2352x1568: 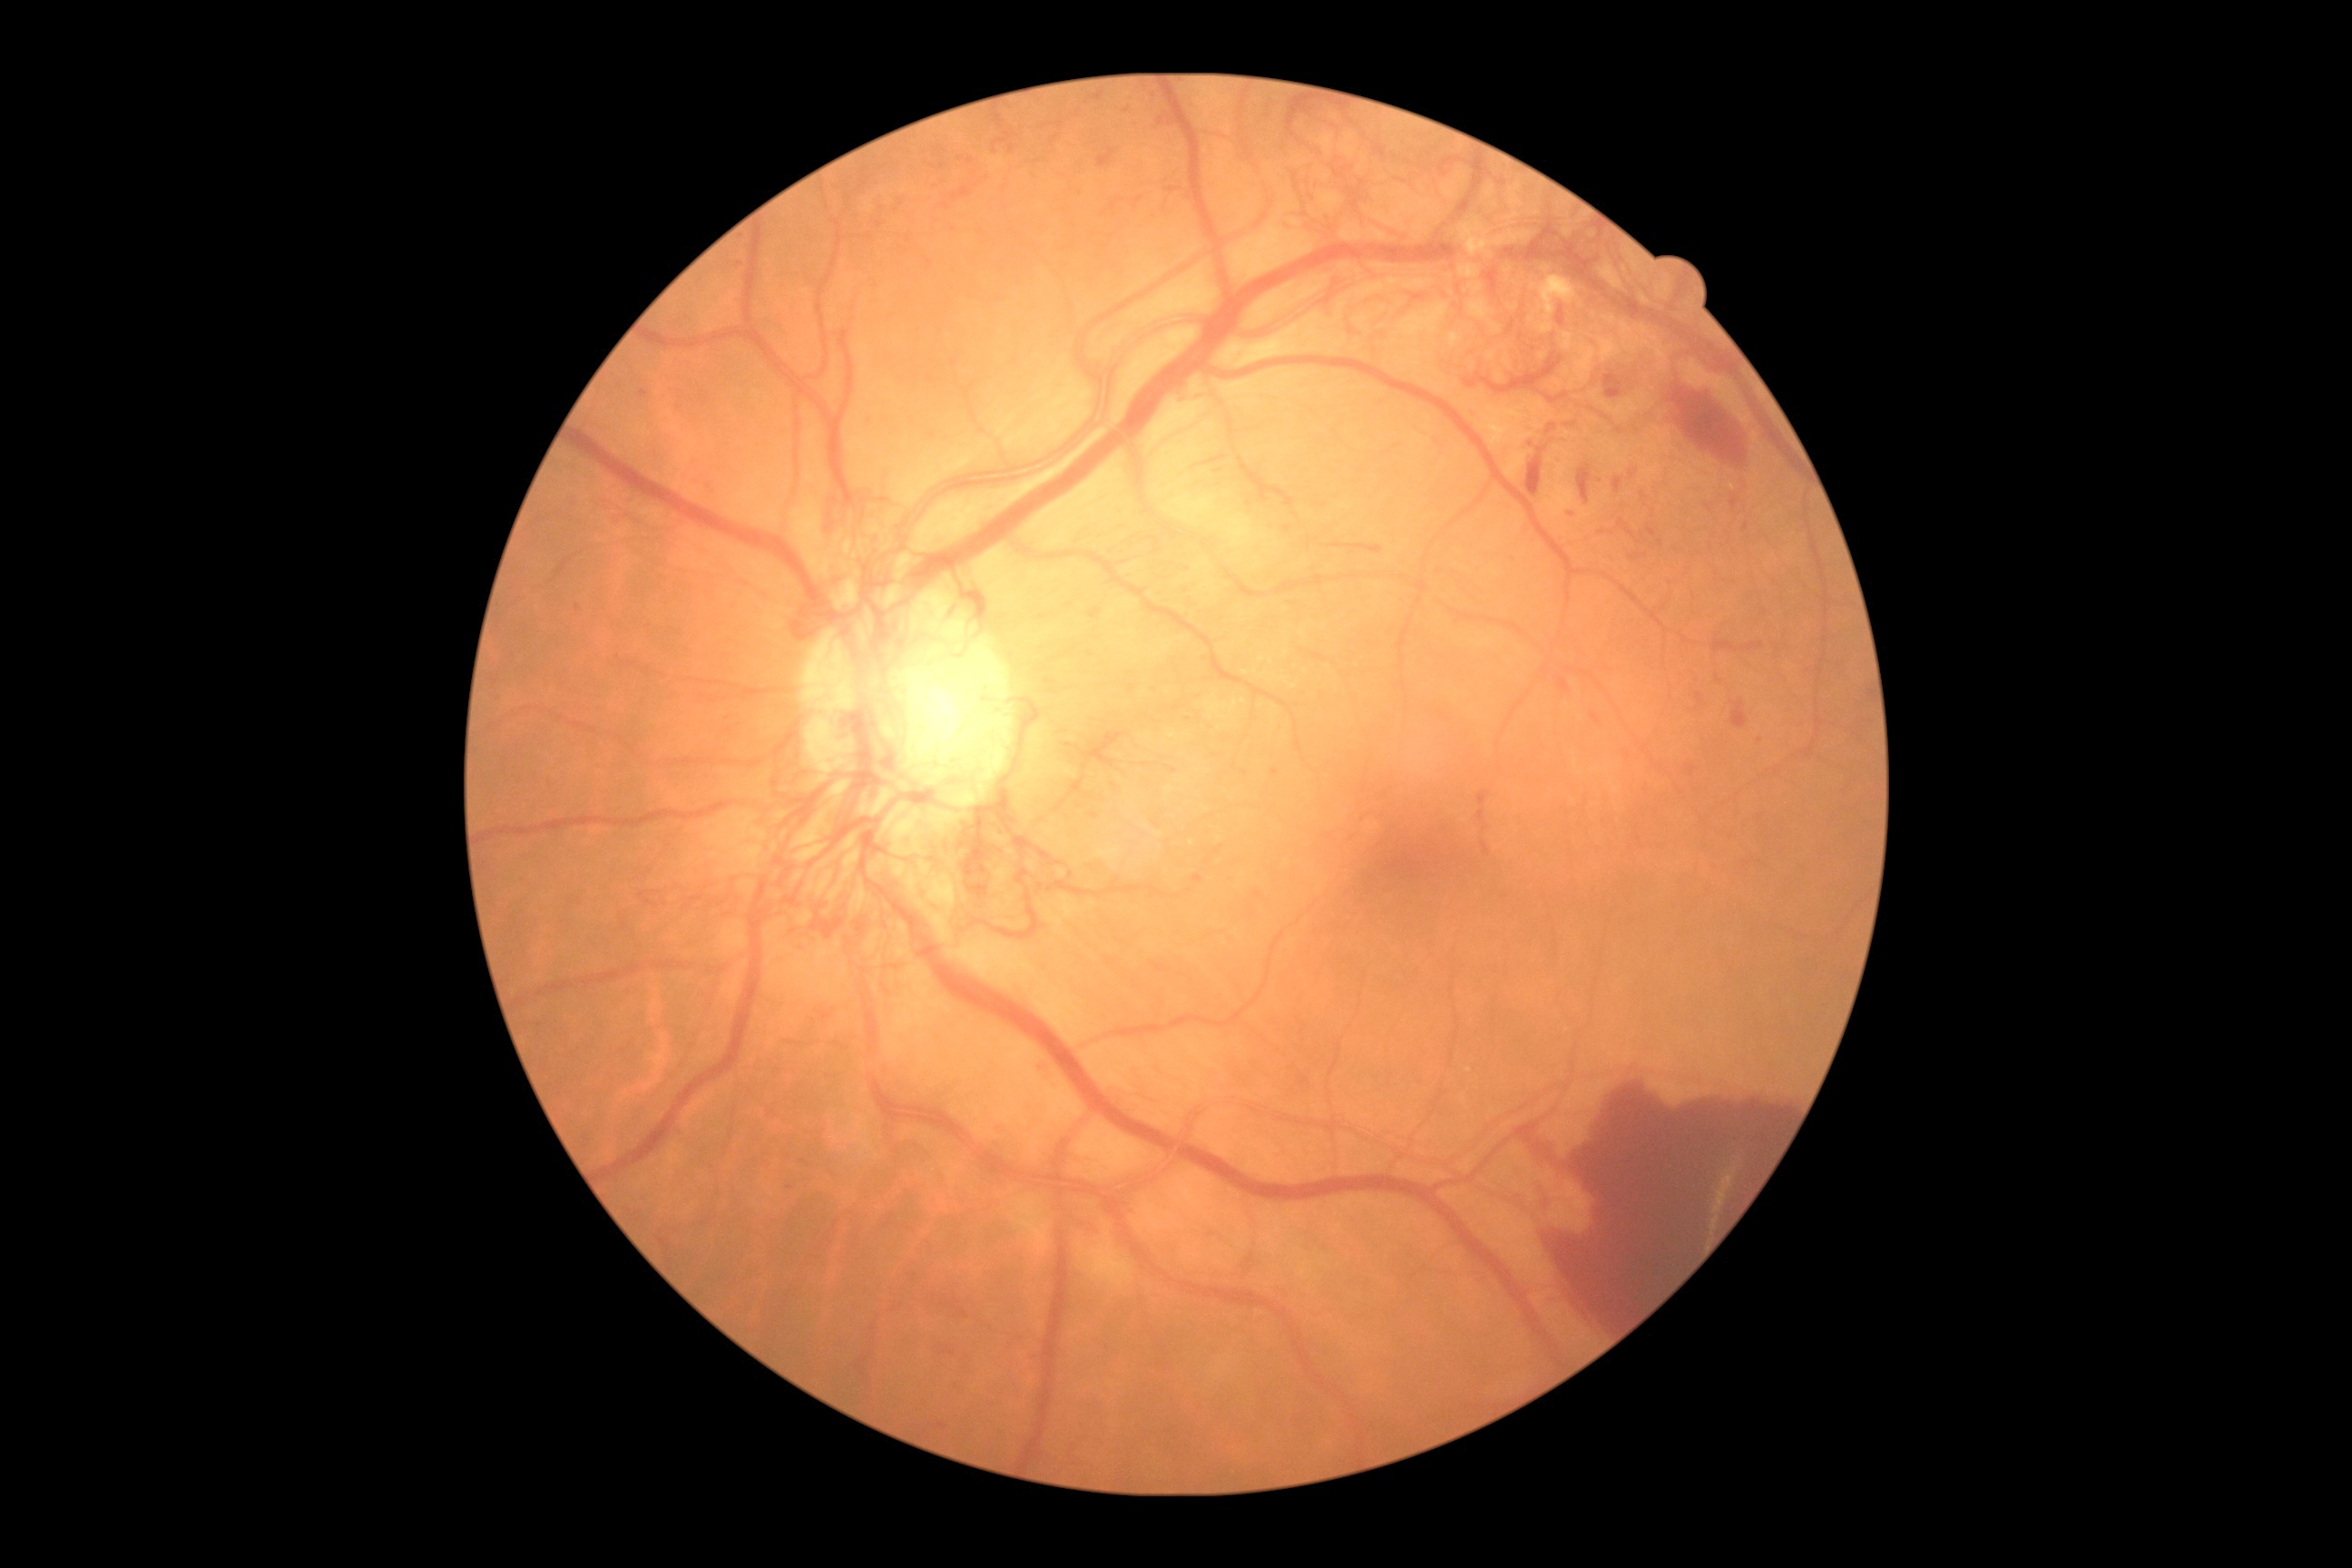
diabetic retinopathy severity: grade 4 (PDR); DR class: proliferative diabetic retinopathy.